45° field of view. Color fundus photograph. 2352 by 1568 pixels.
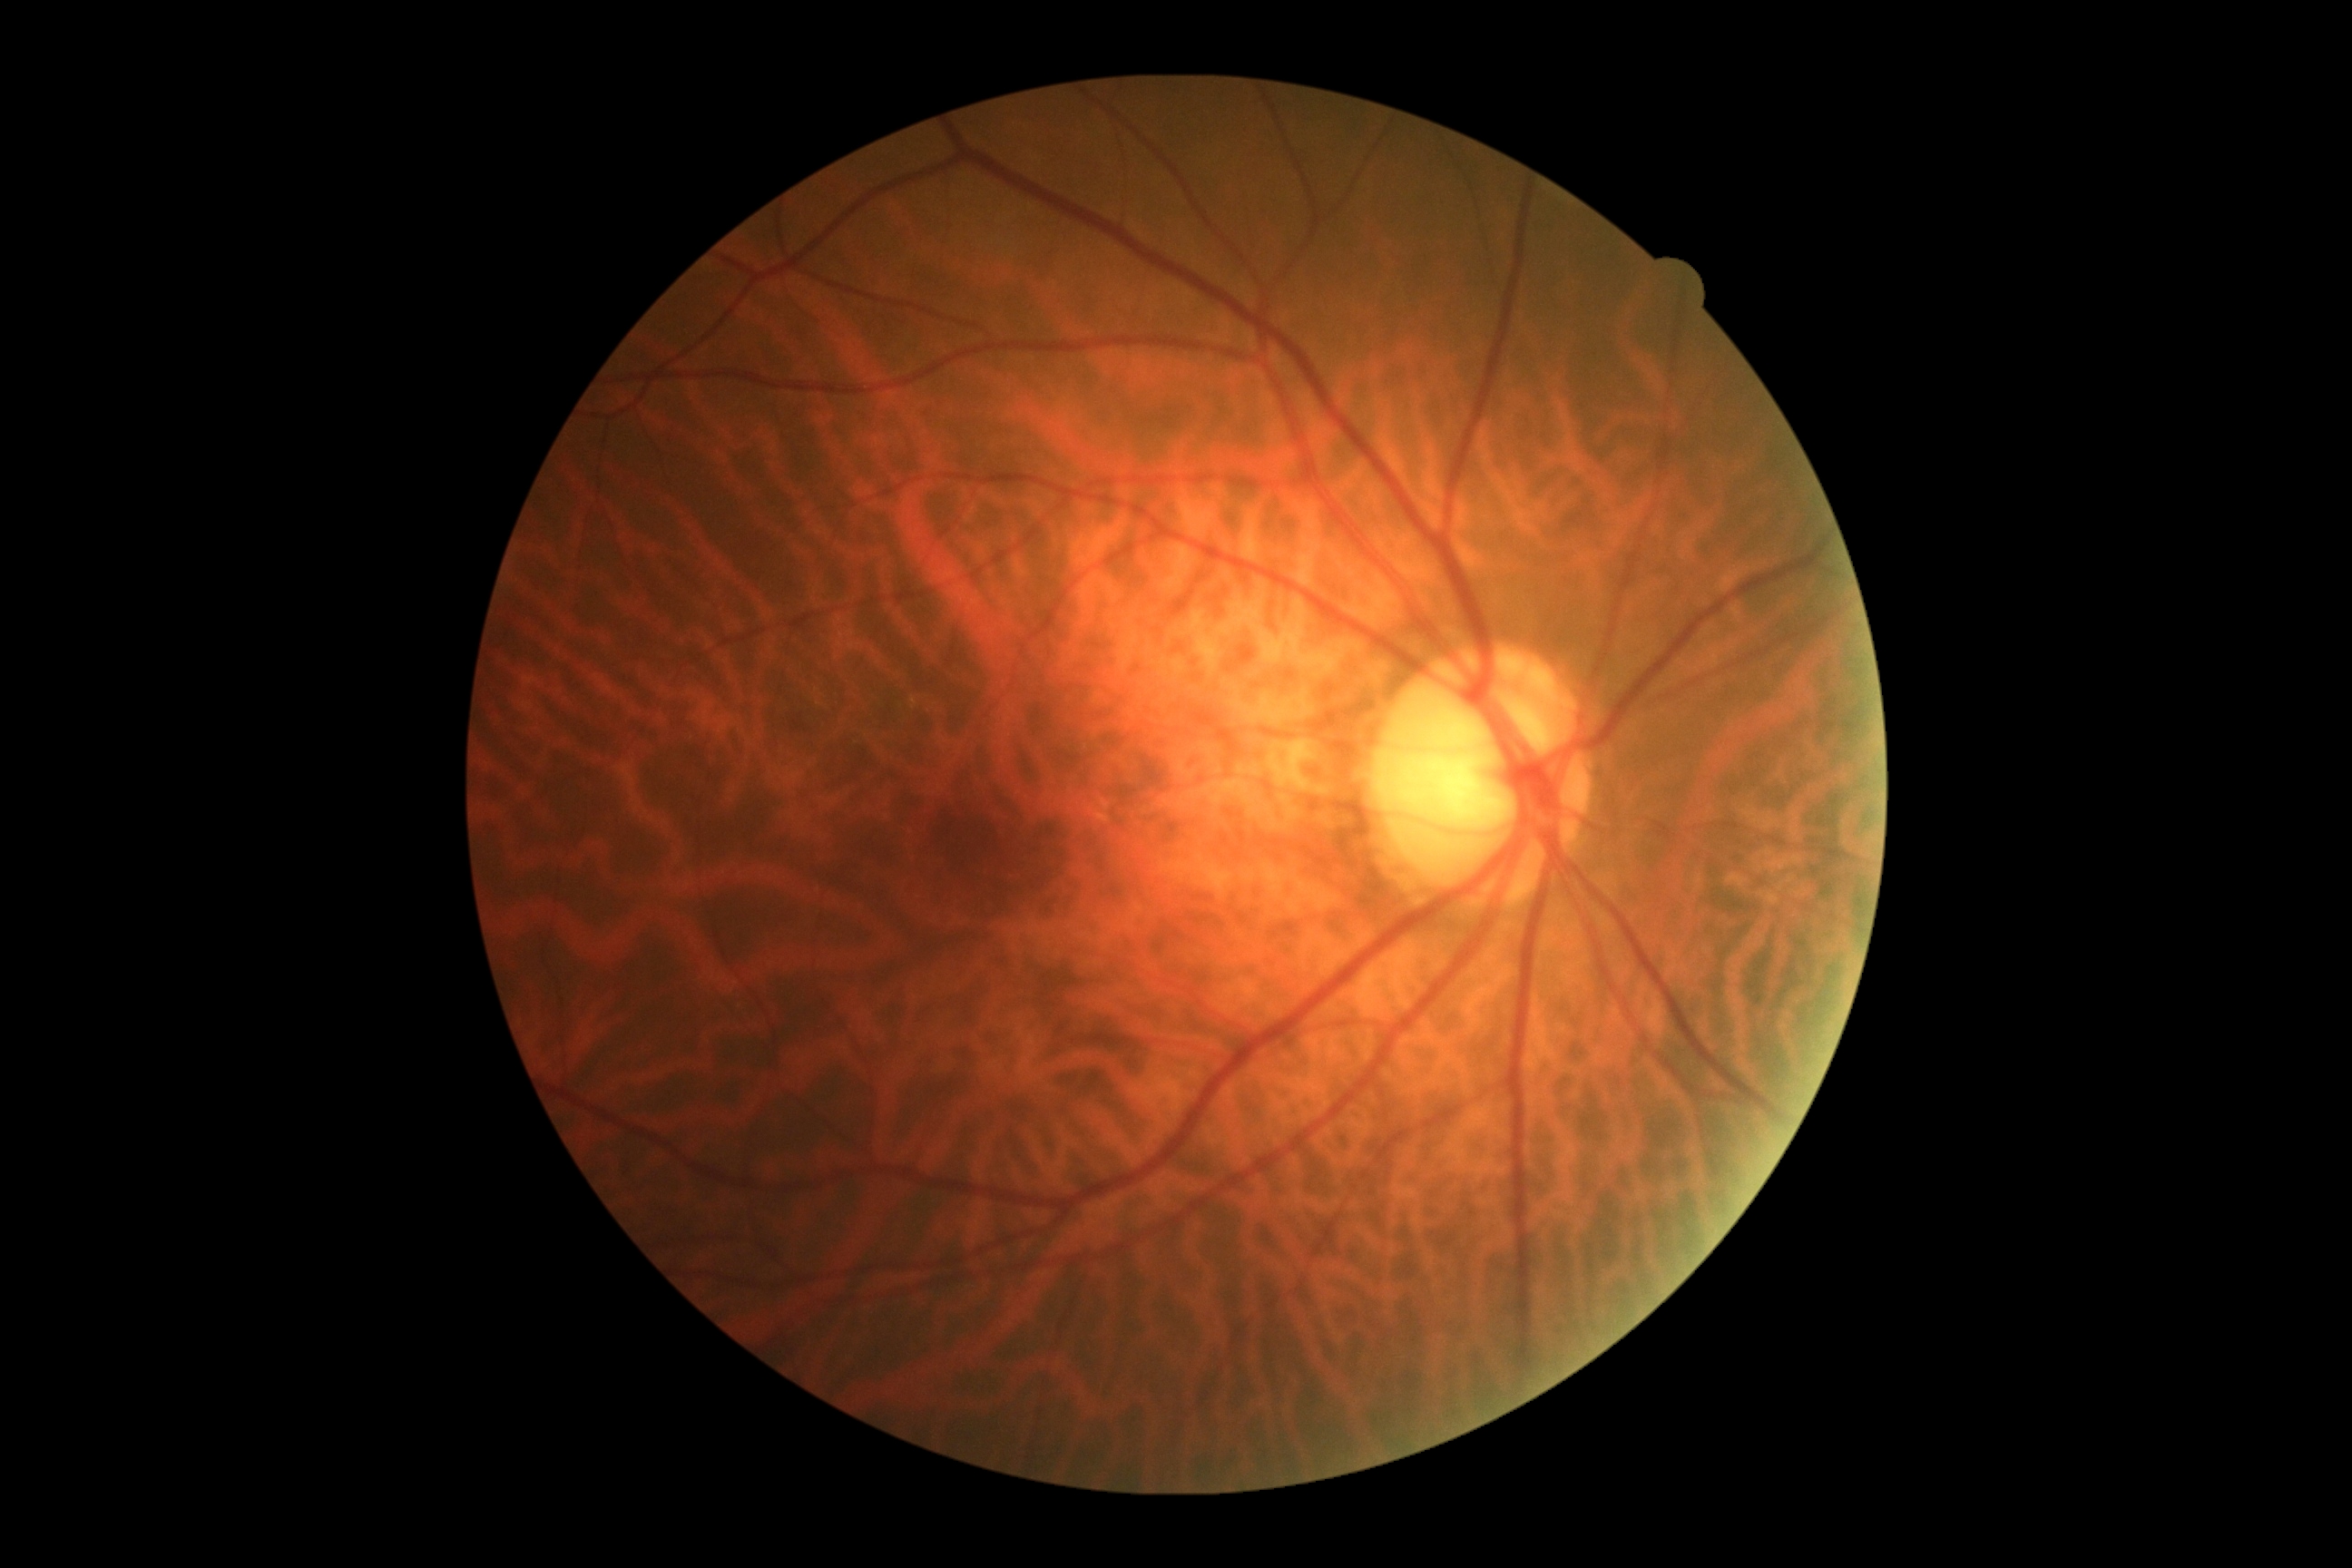

retinopathy: no apparent retinopathy (grade 0) | DR impression: no apparent DR.